Without pupil dilation
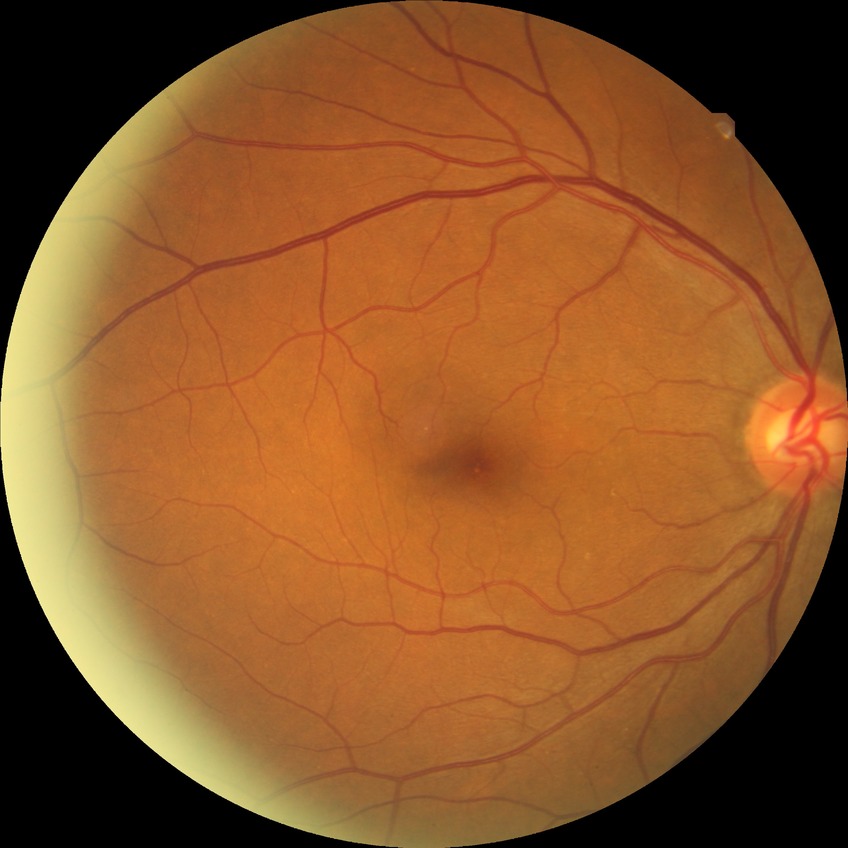

Diabetic retinopathy (DR): NDR (no diabetic retinopathy).